Wide-field contact fundus photograph of an infant: 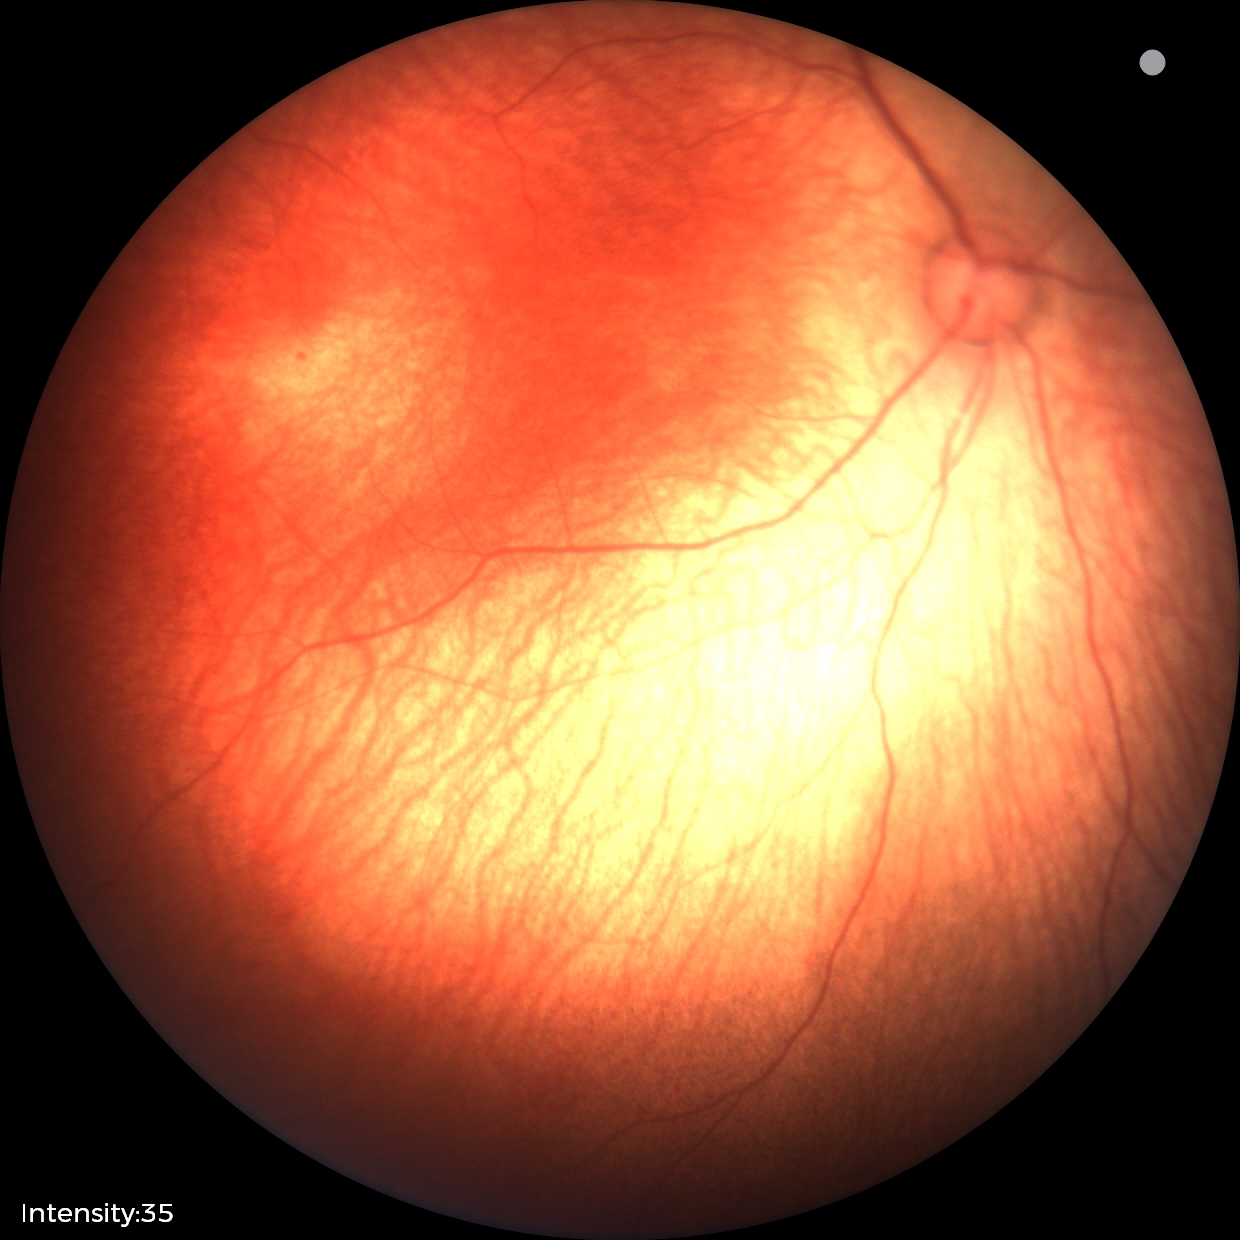 Screening examination diagnosed as physiological.